130° field of view (Clarity RetCam 3). Wide-field fundus photograph of an infant. 640 x 480 pixels — 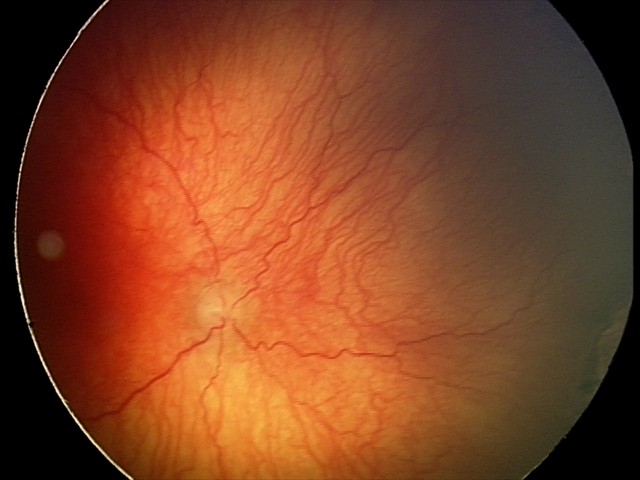 With plus disease. Examination diagnosed as aggressive retinopathy of prematurity (A-ROP).